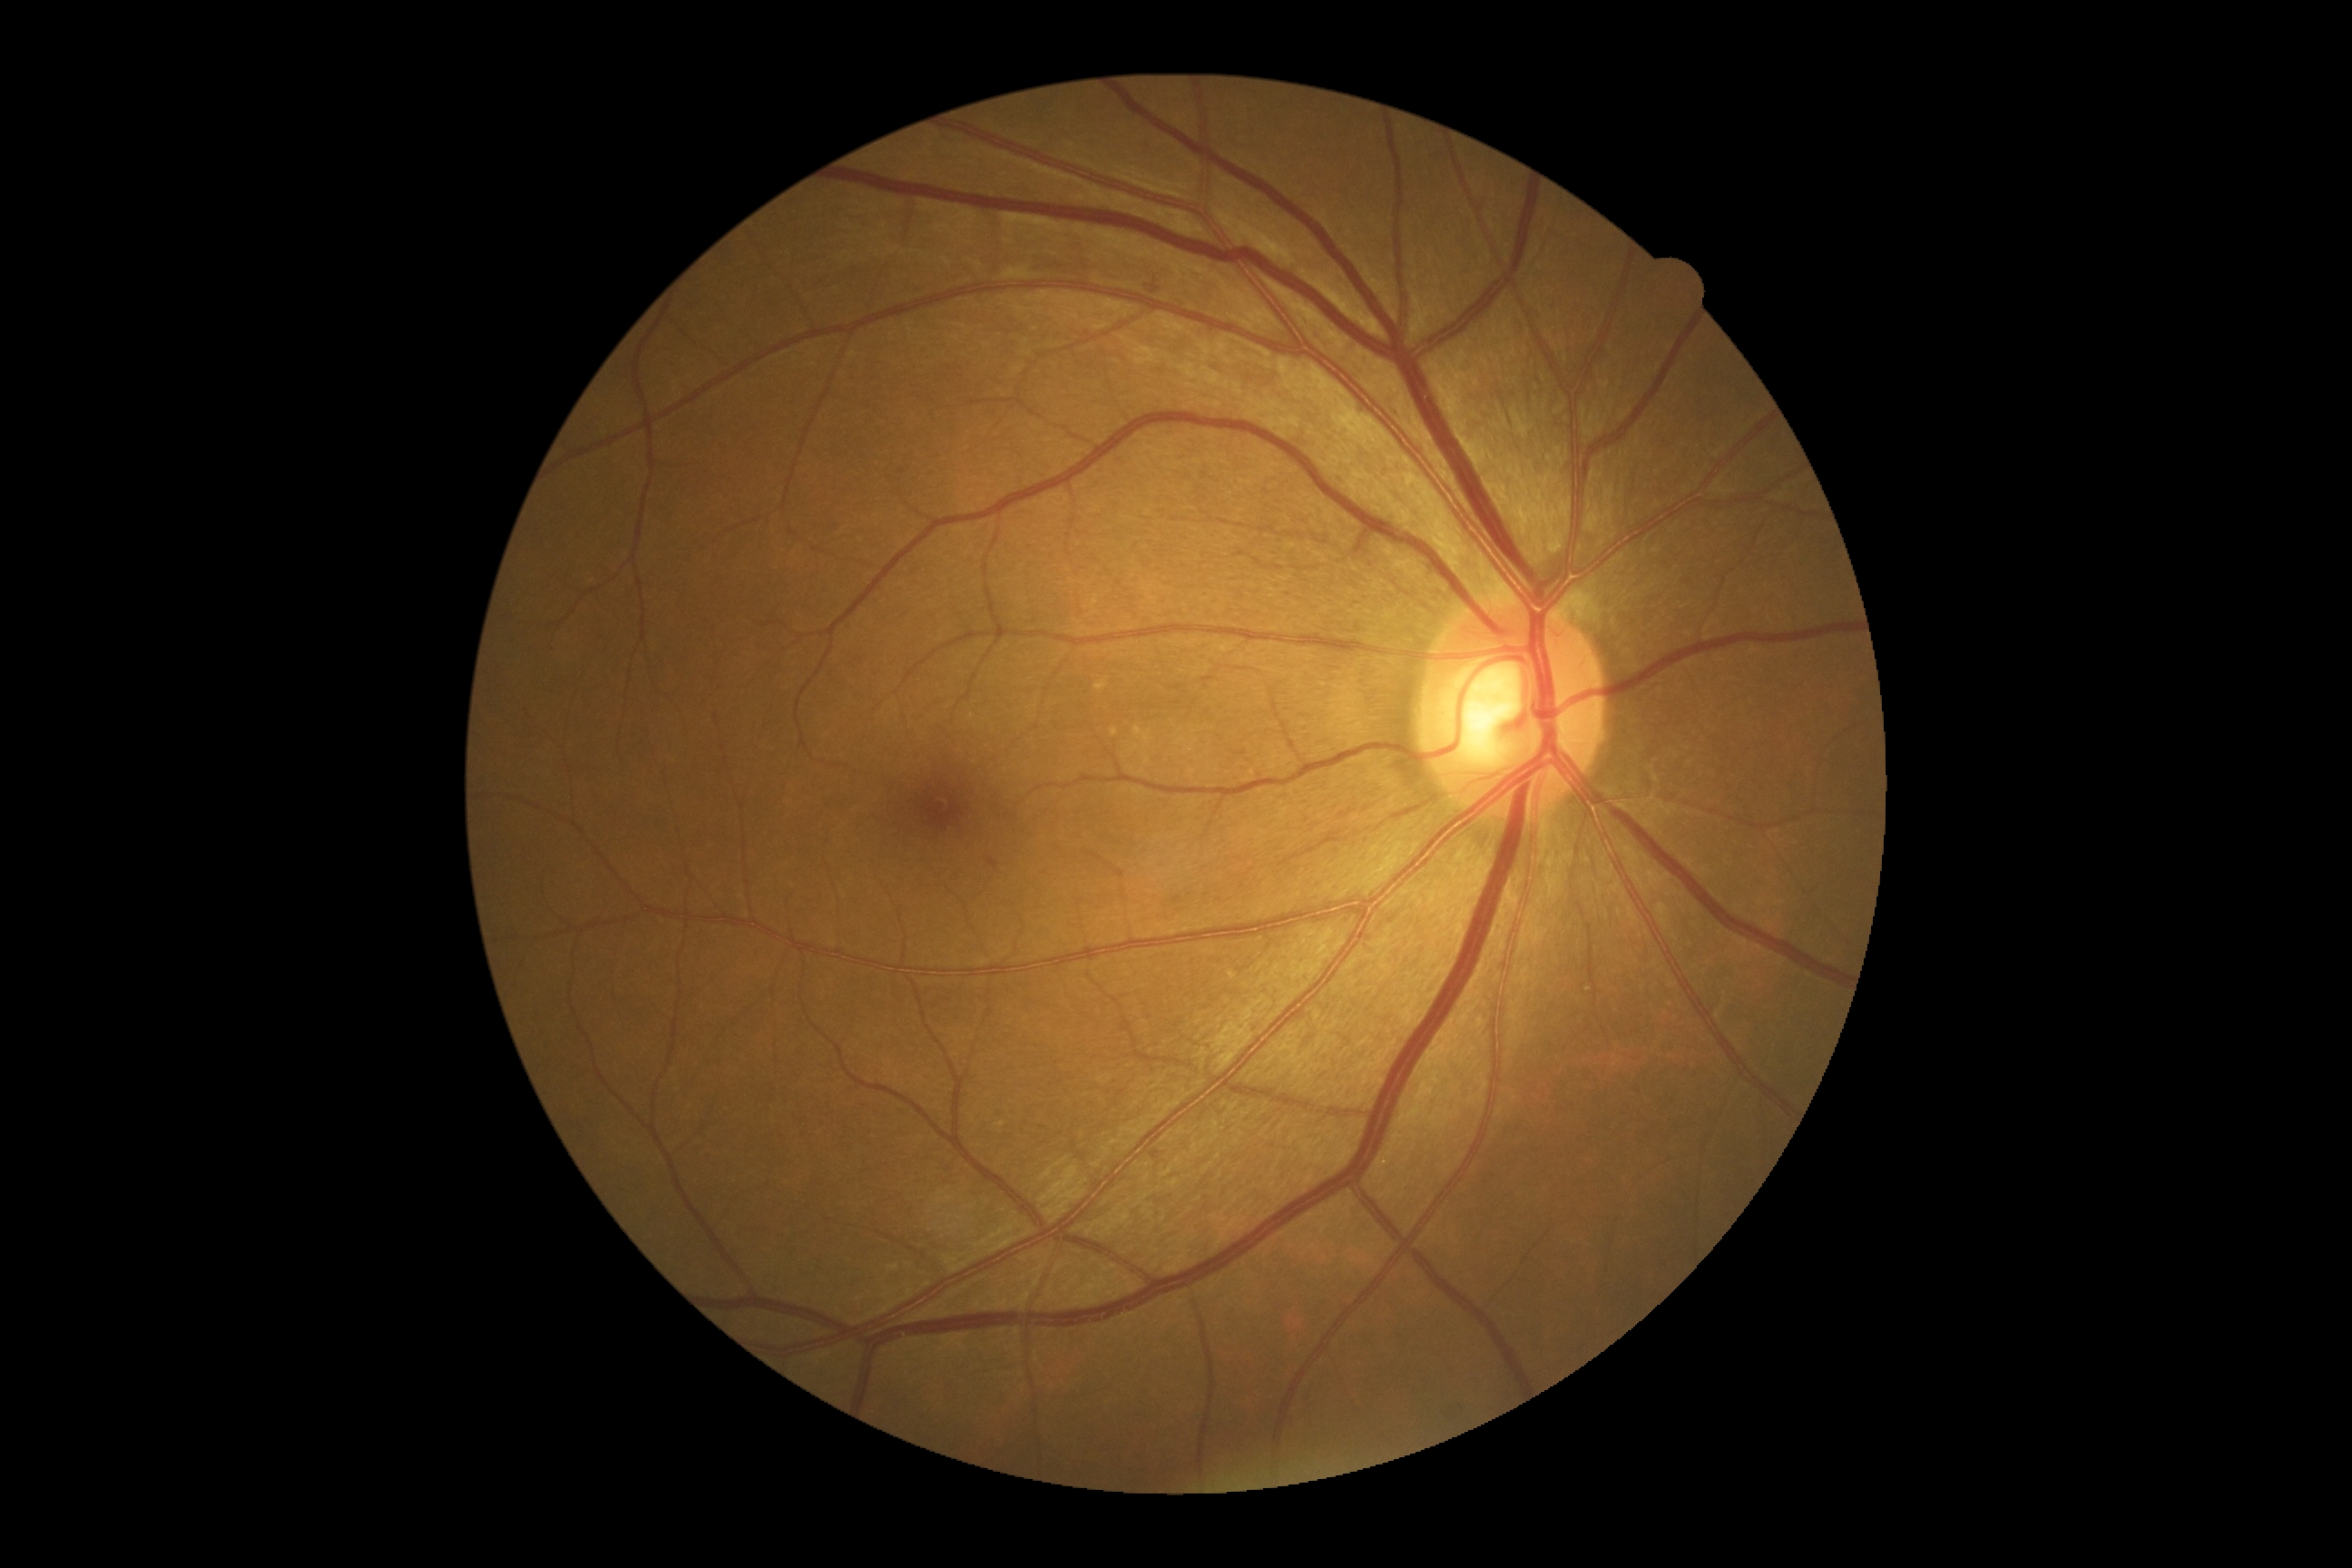

Diabetic retinopathy severity: 2 — more than just microaneurysms but less than severe NPDR.
Disease class: non-proliferative diabetic retinopathy.